CFP, 45-degree field of view — 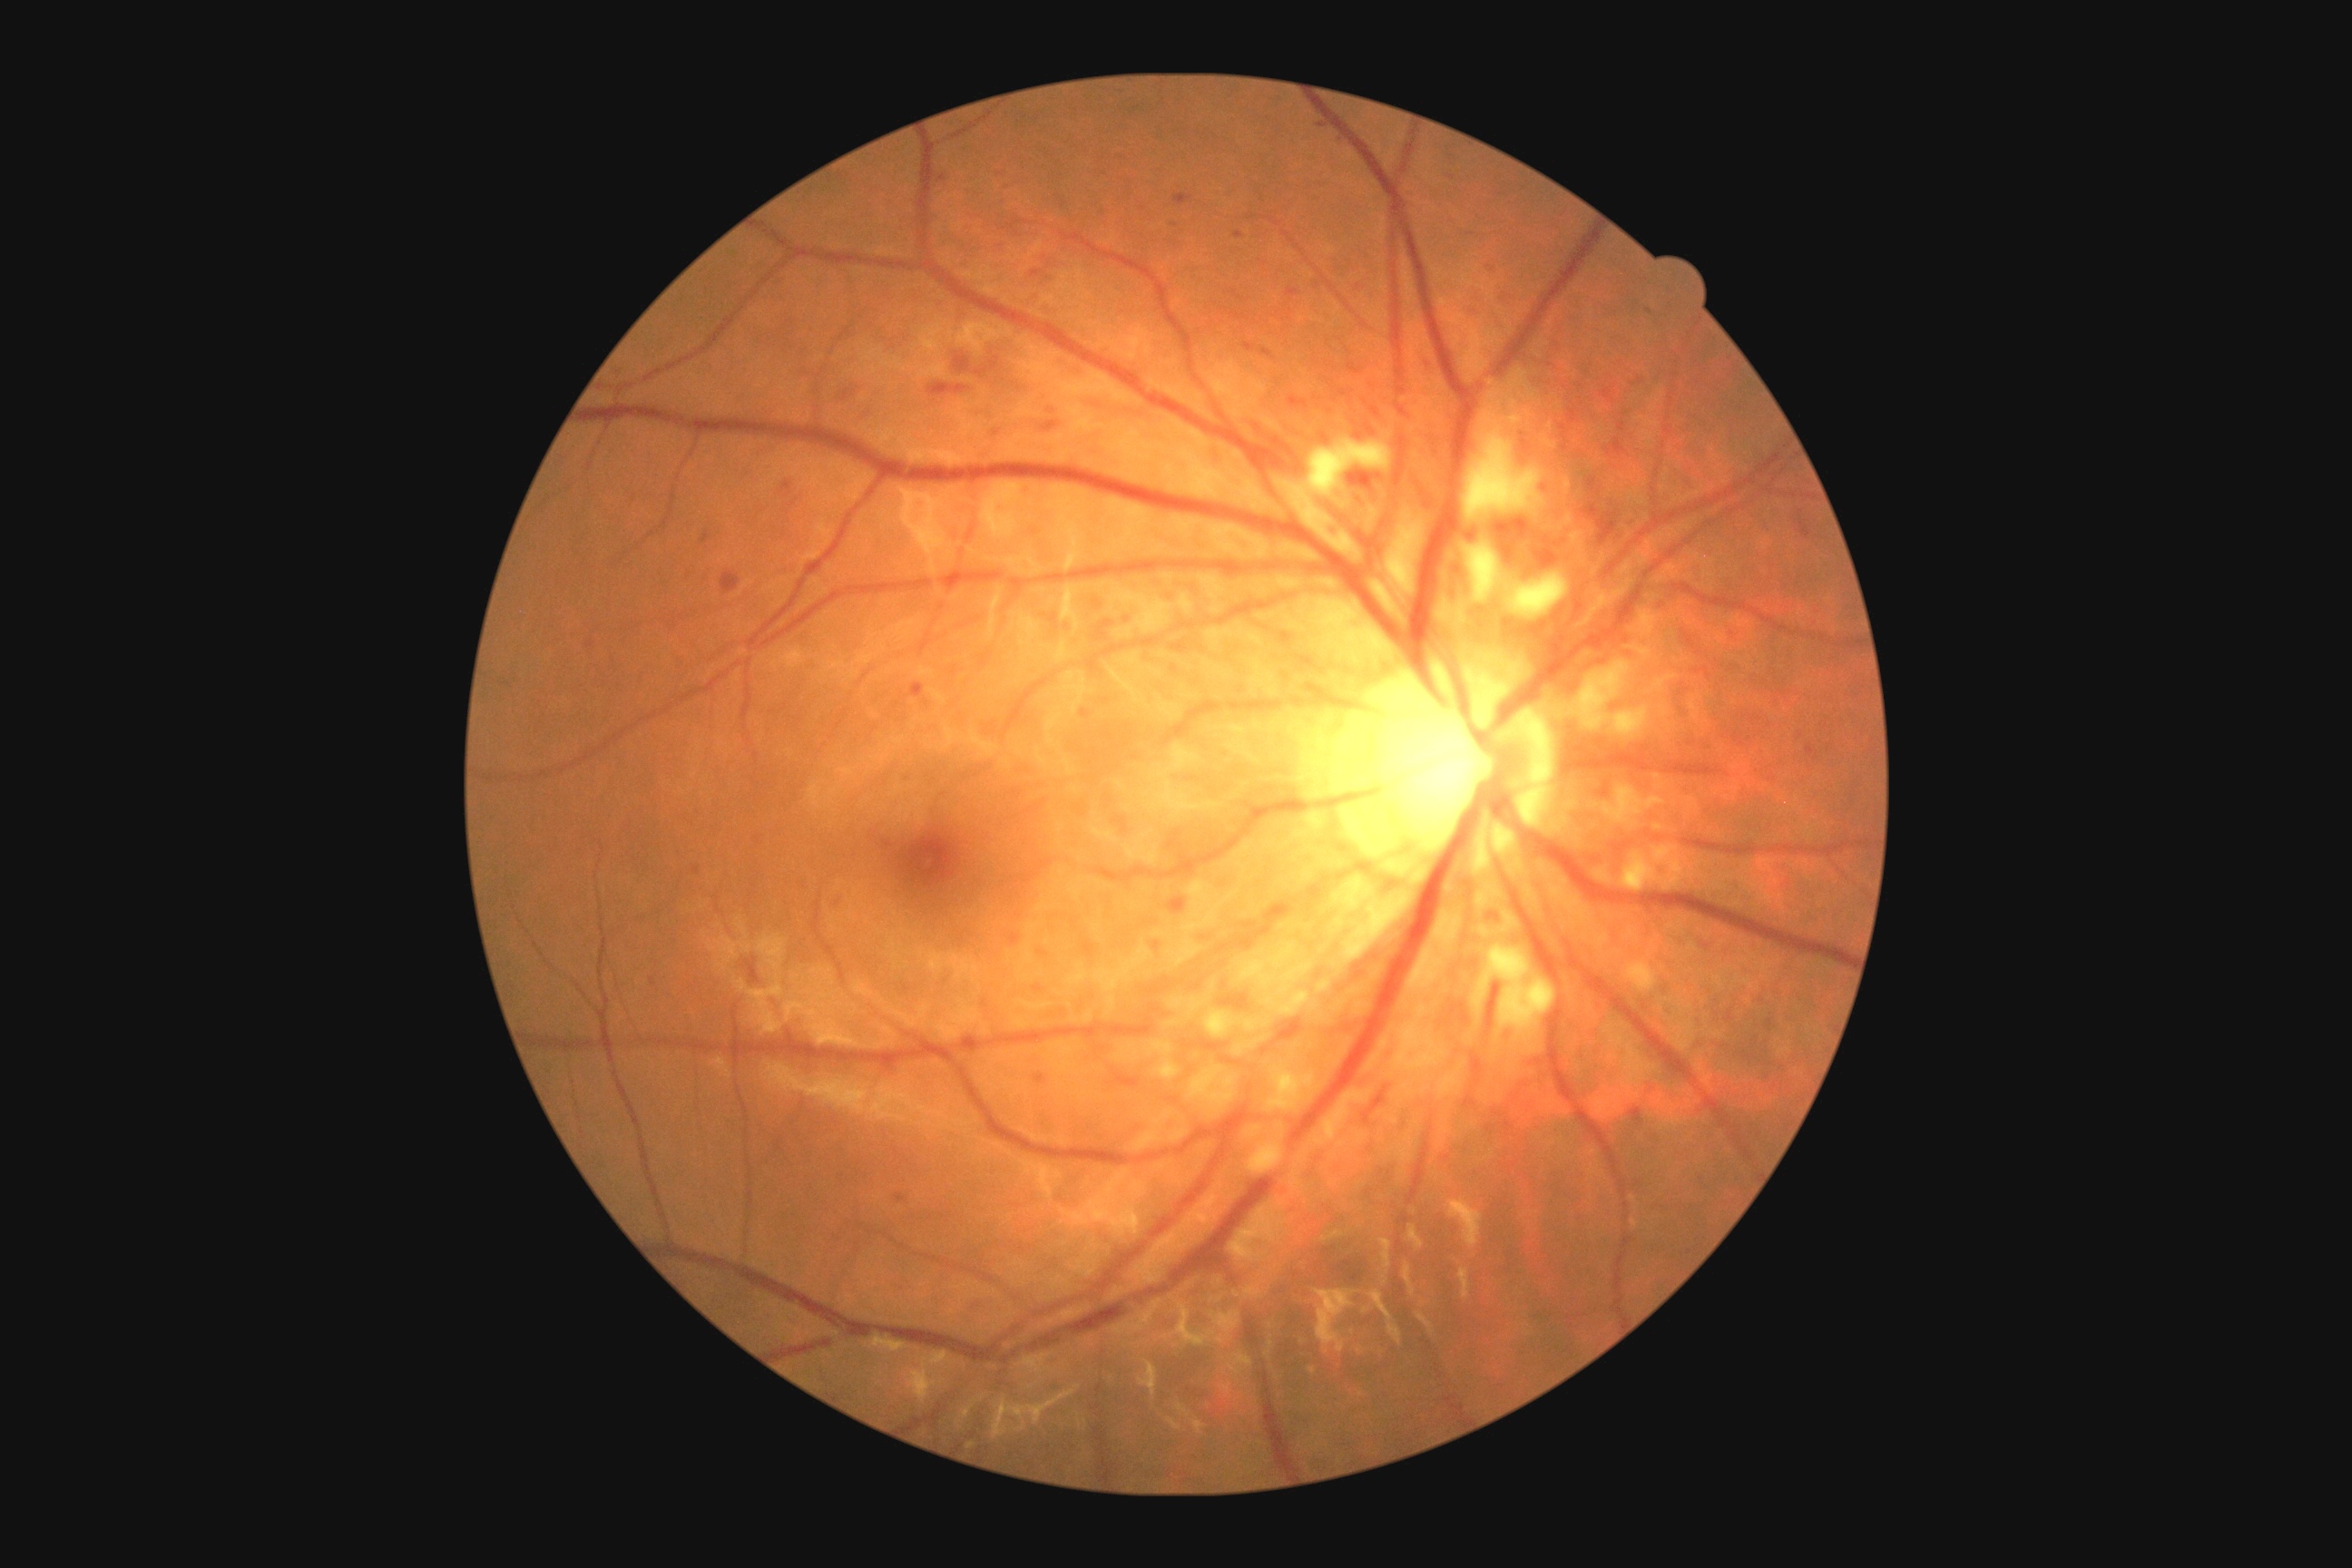
{"dr_grade": "moderate non-proliferative diabetic retinopathy (grade 2)"}